2361 x 1568 pixels:
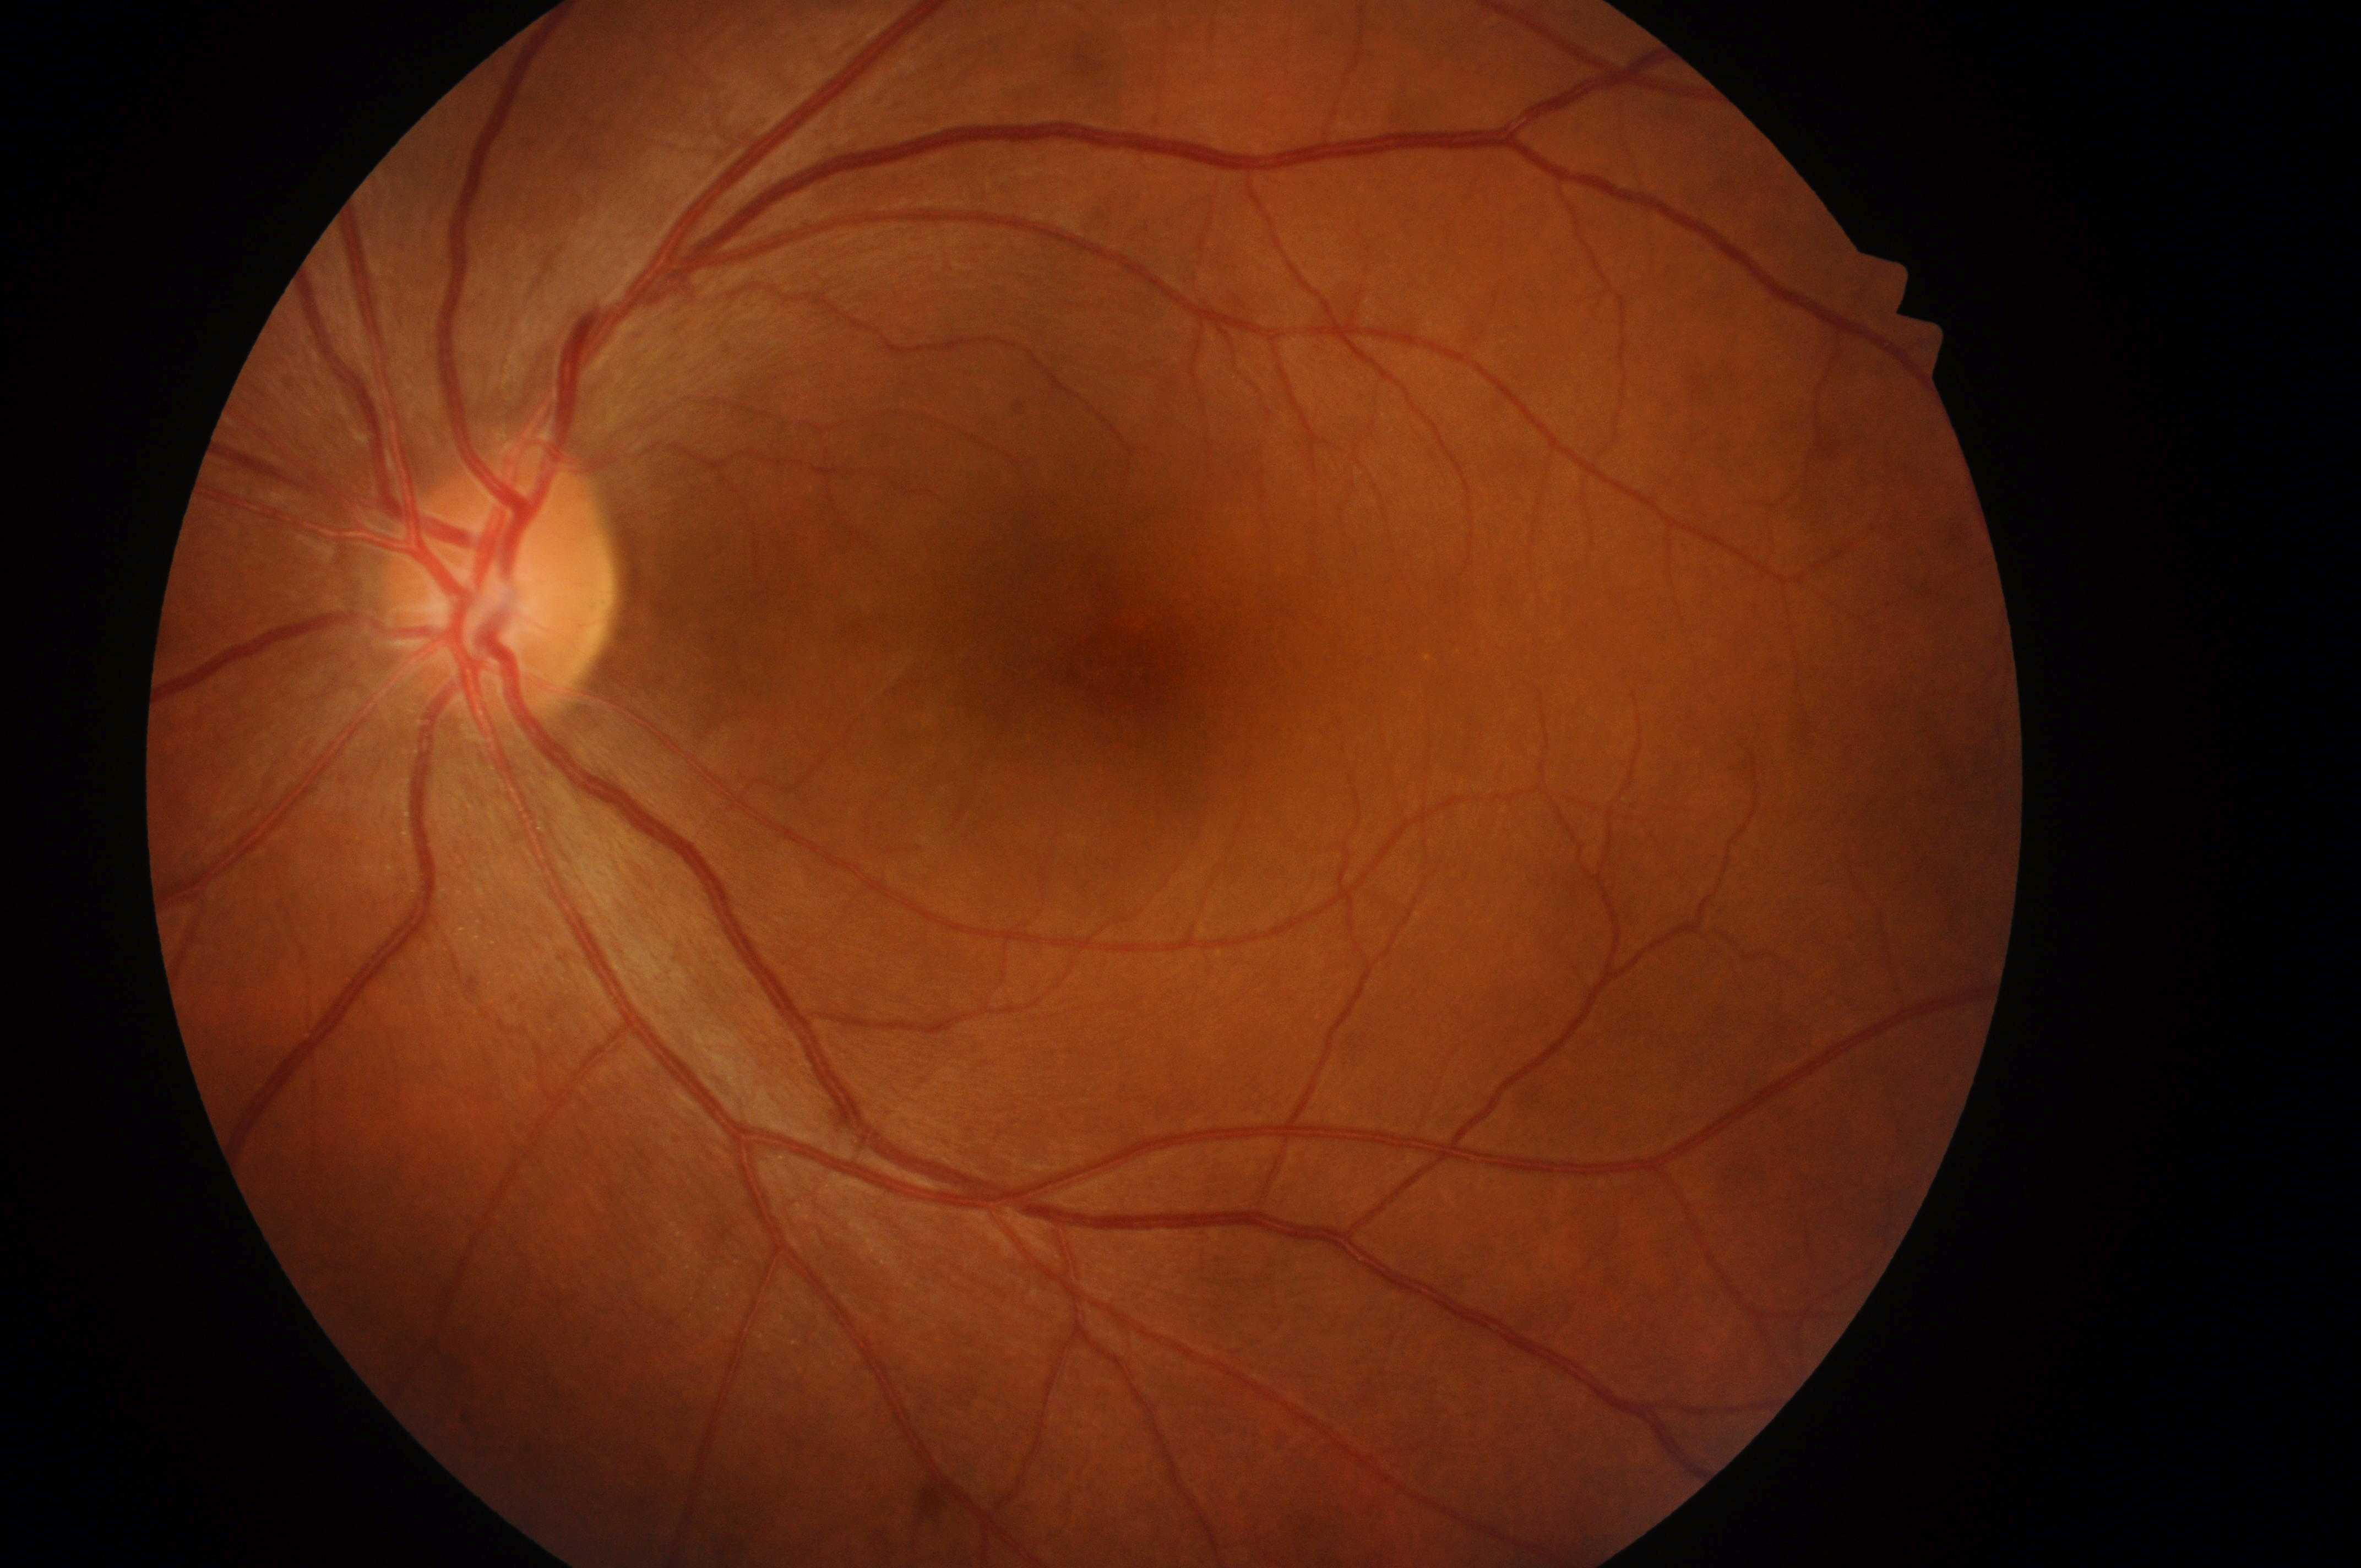
{
  "dr_grade": "0 (no apparent retinopathy)",
  "eye": "the left eye",
  "fovea": "1132px, 670px",
  "optic_disc": "491px, 600px",
  "dme_grade": "no risk (grade 0)"
}